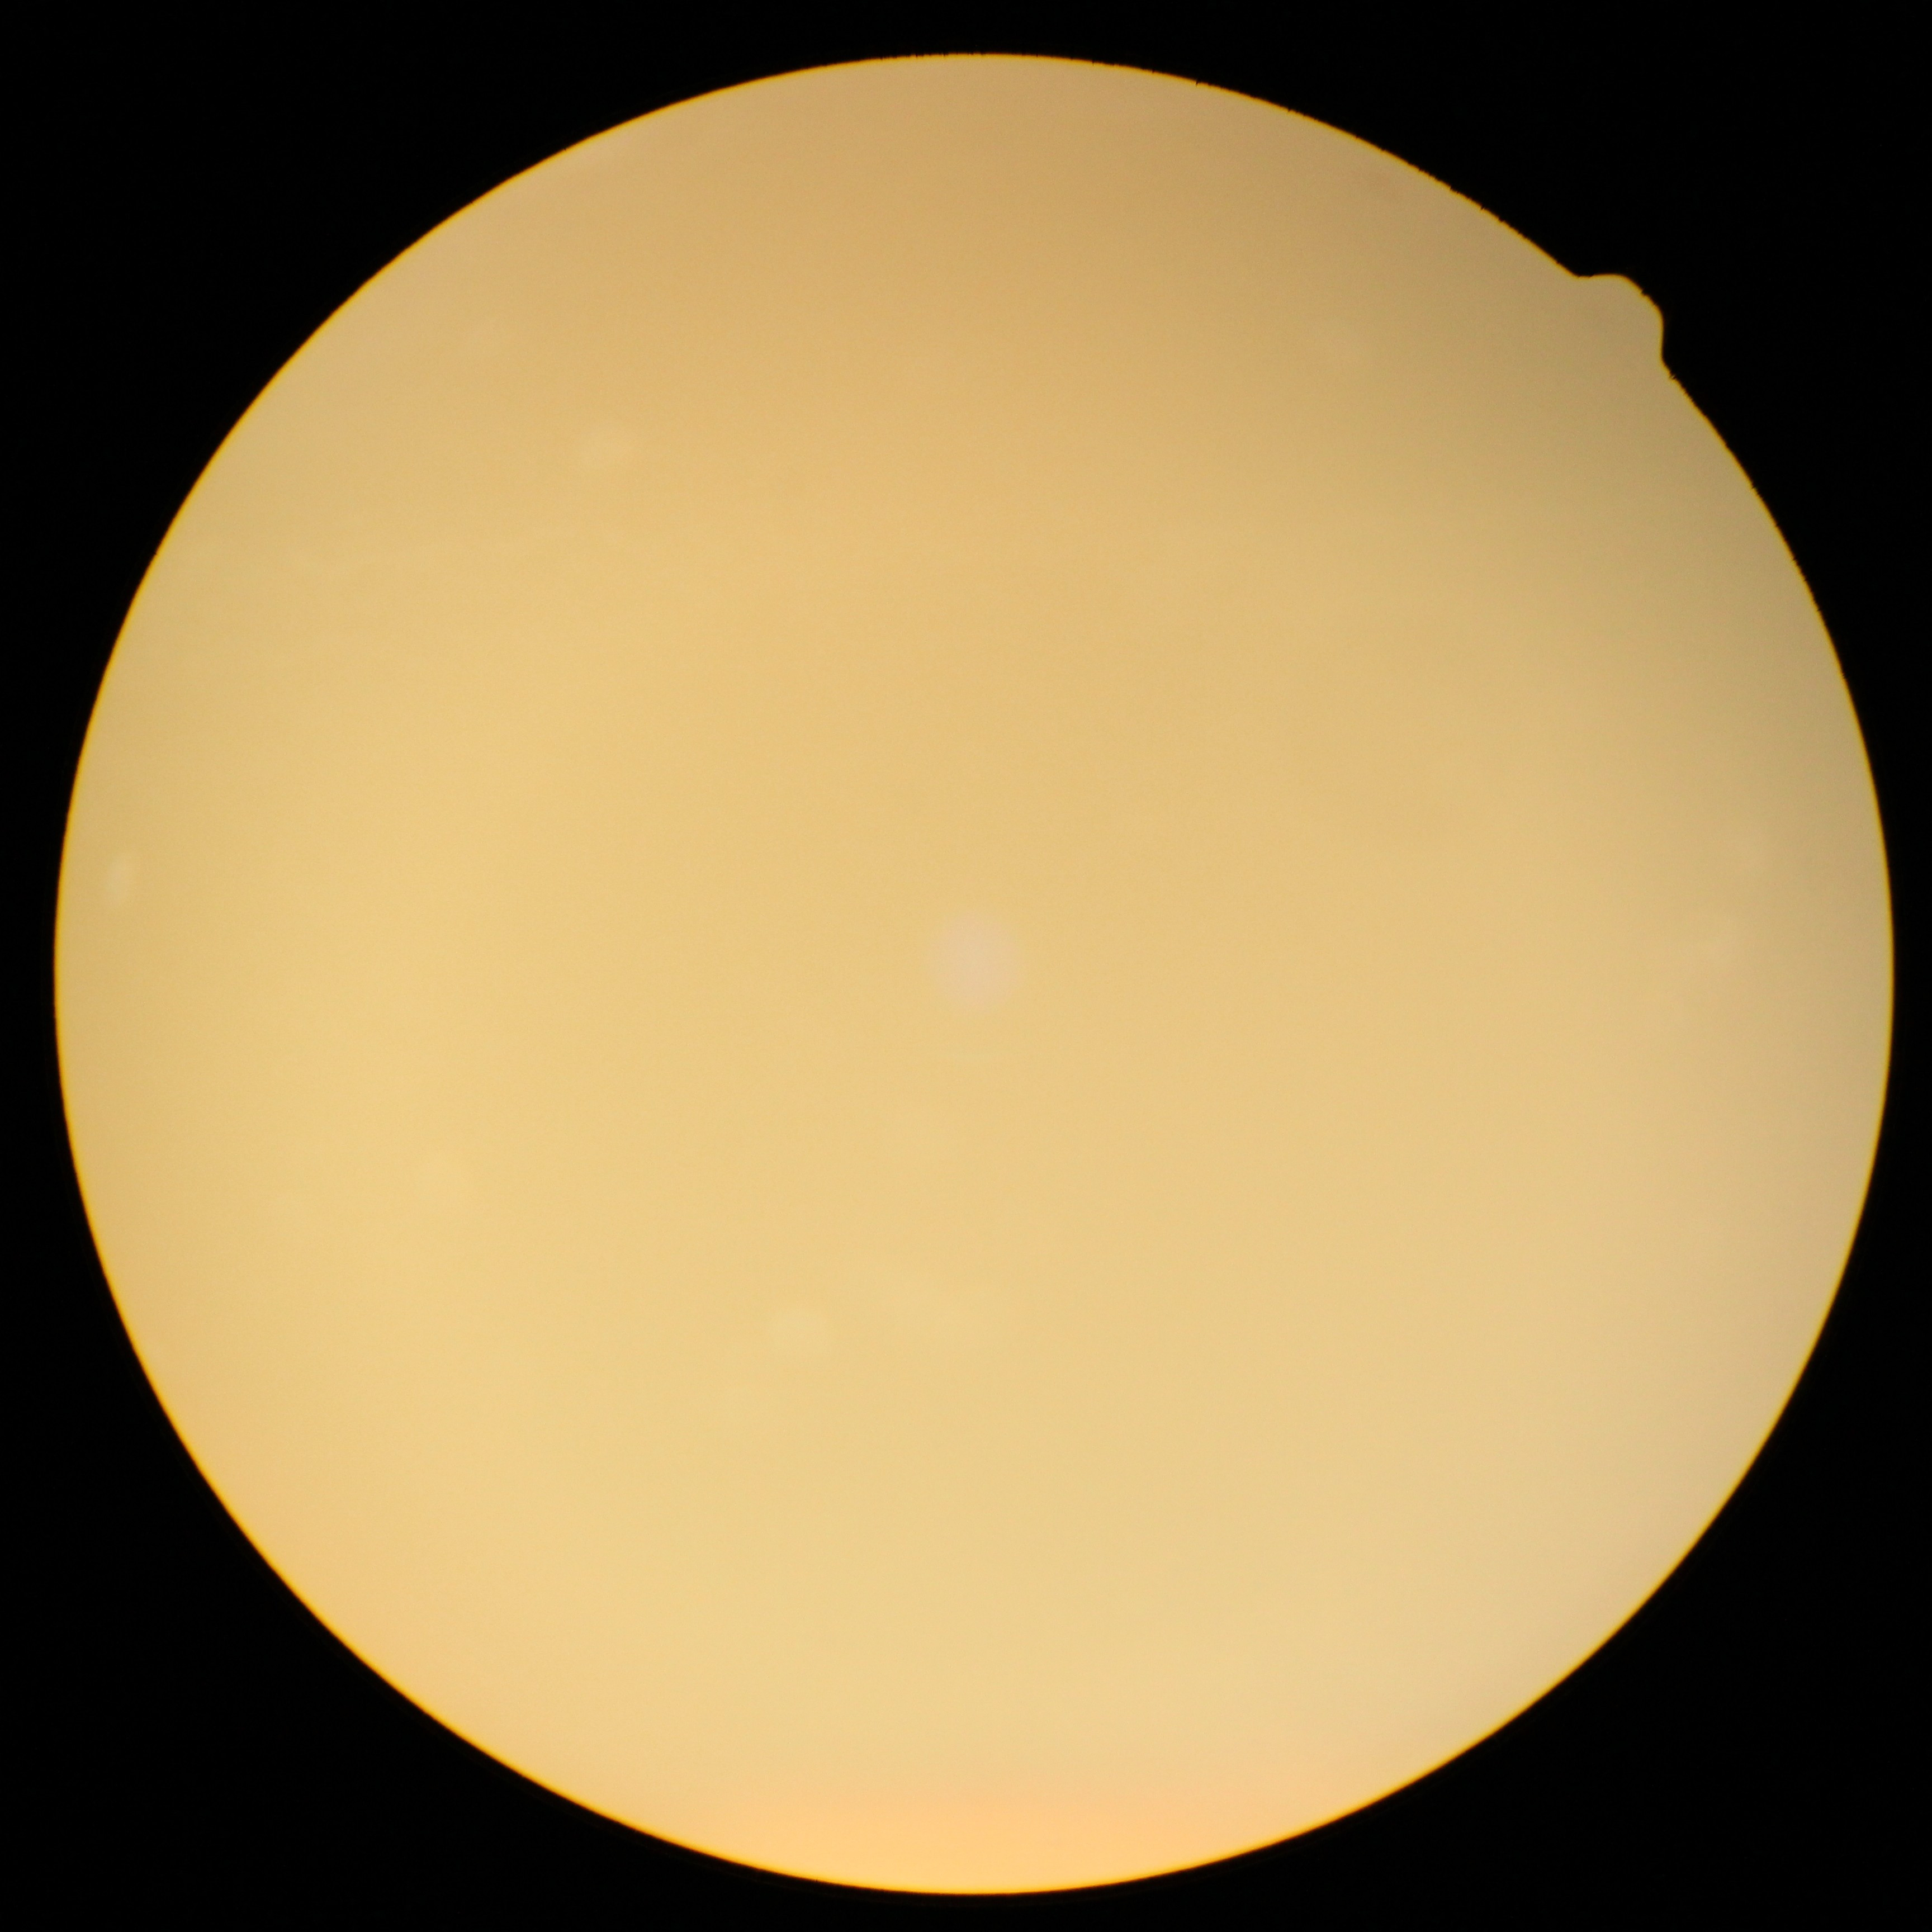
Retinopathy is ungradable due to poor image quality.